Pediatric wide-field fundus photograph. 1440 by 1080 pixels. Camera: Natus RetCam Envision (130° FOV).
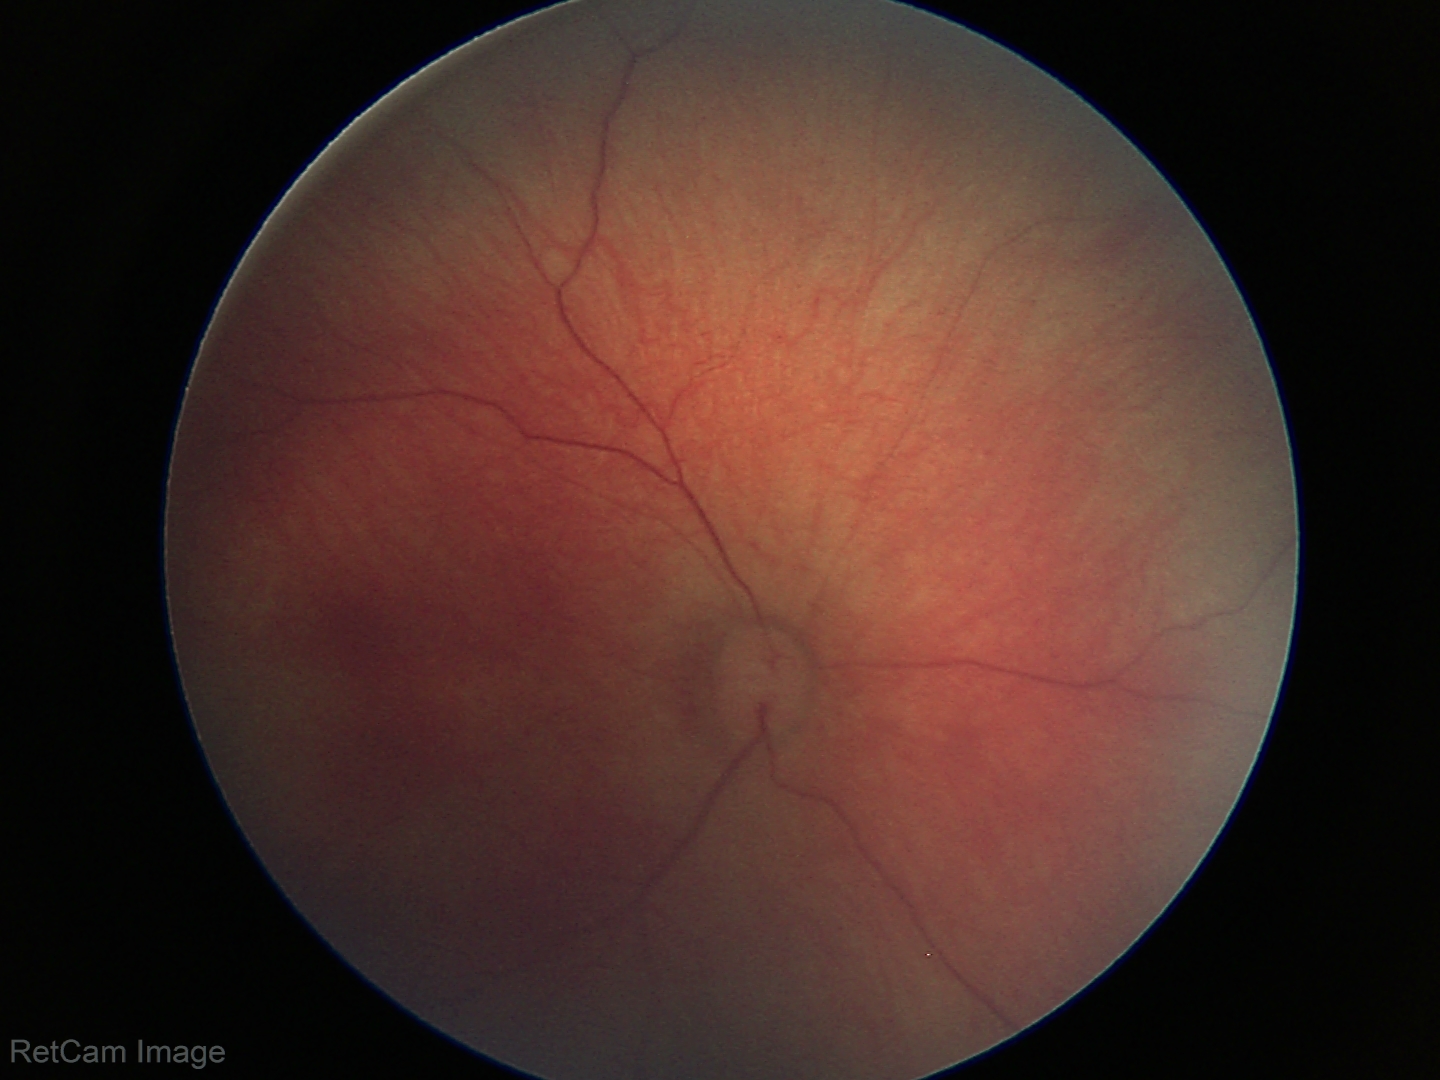
Screening diagnosis = physiological appearance.